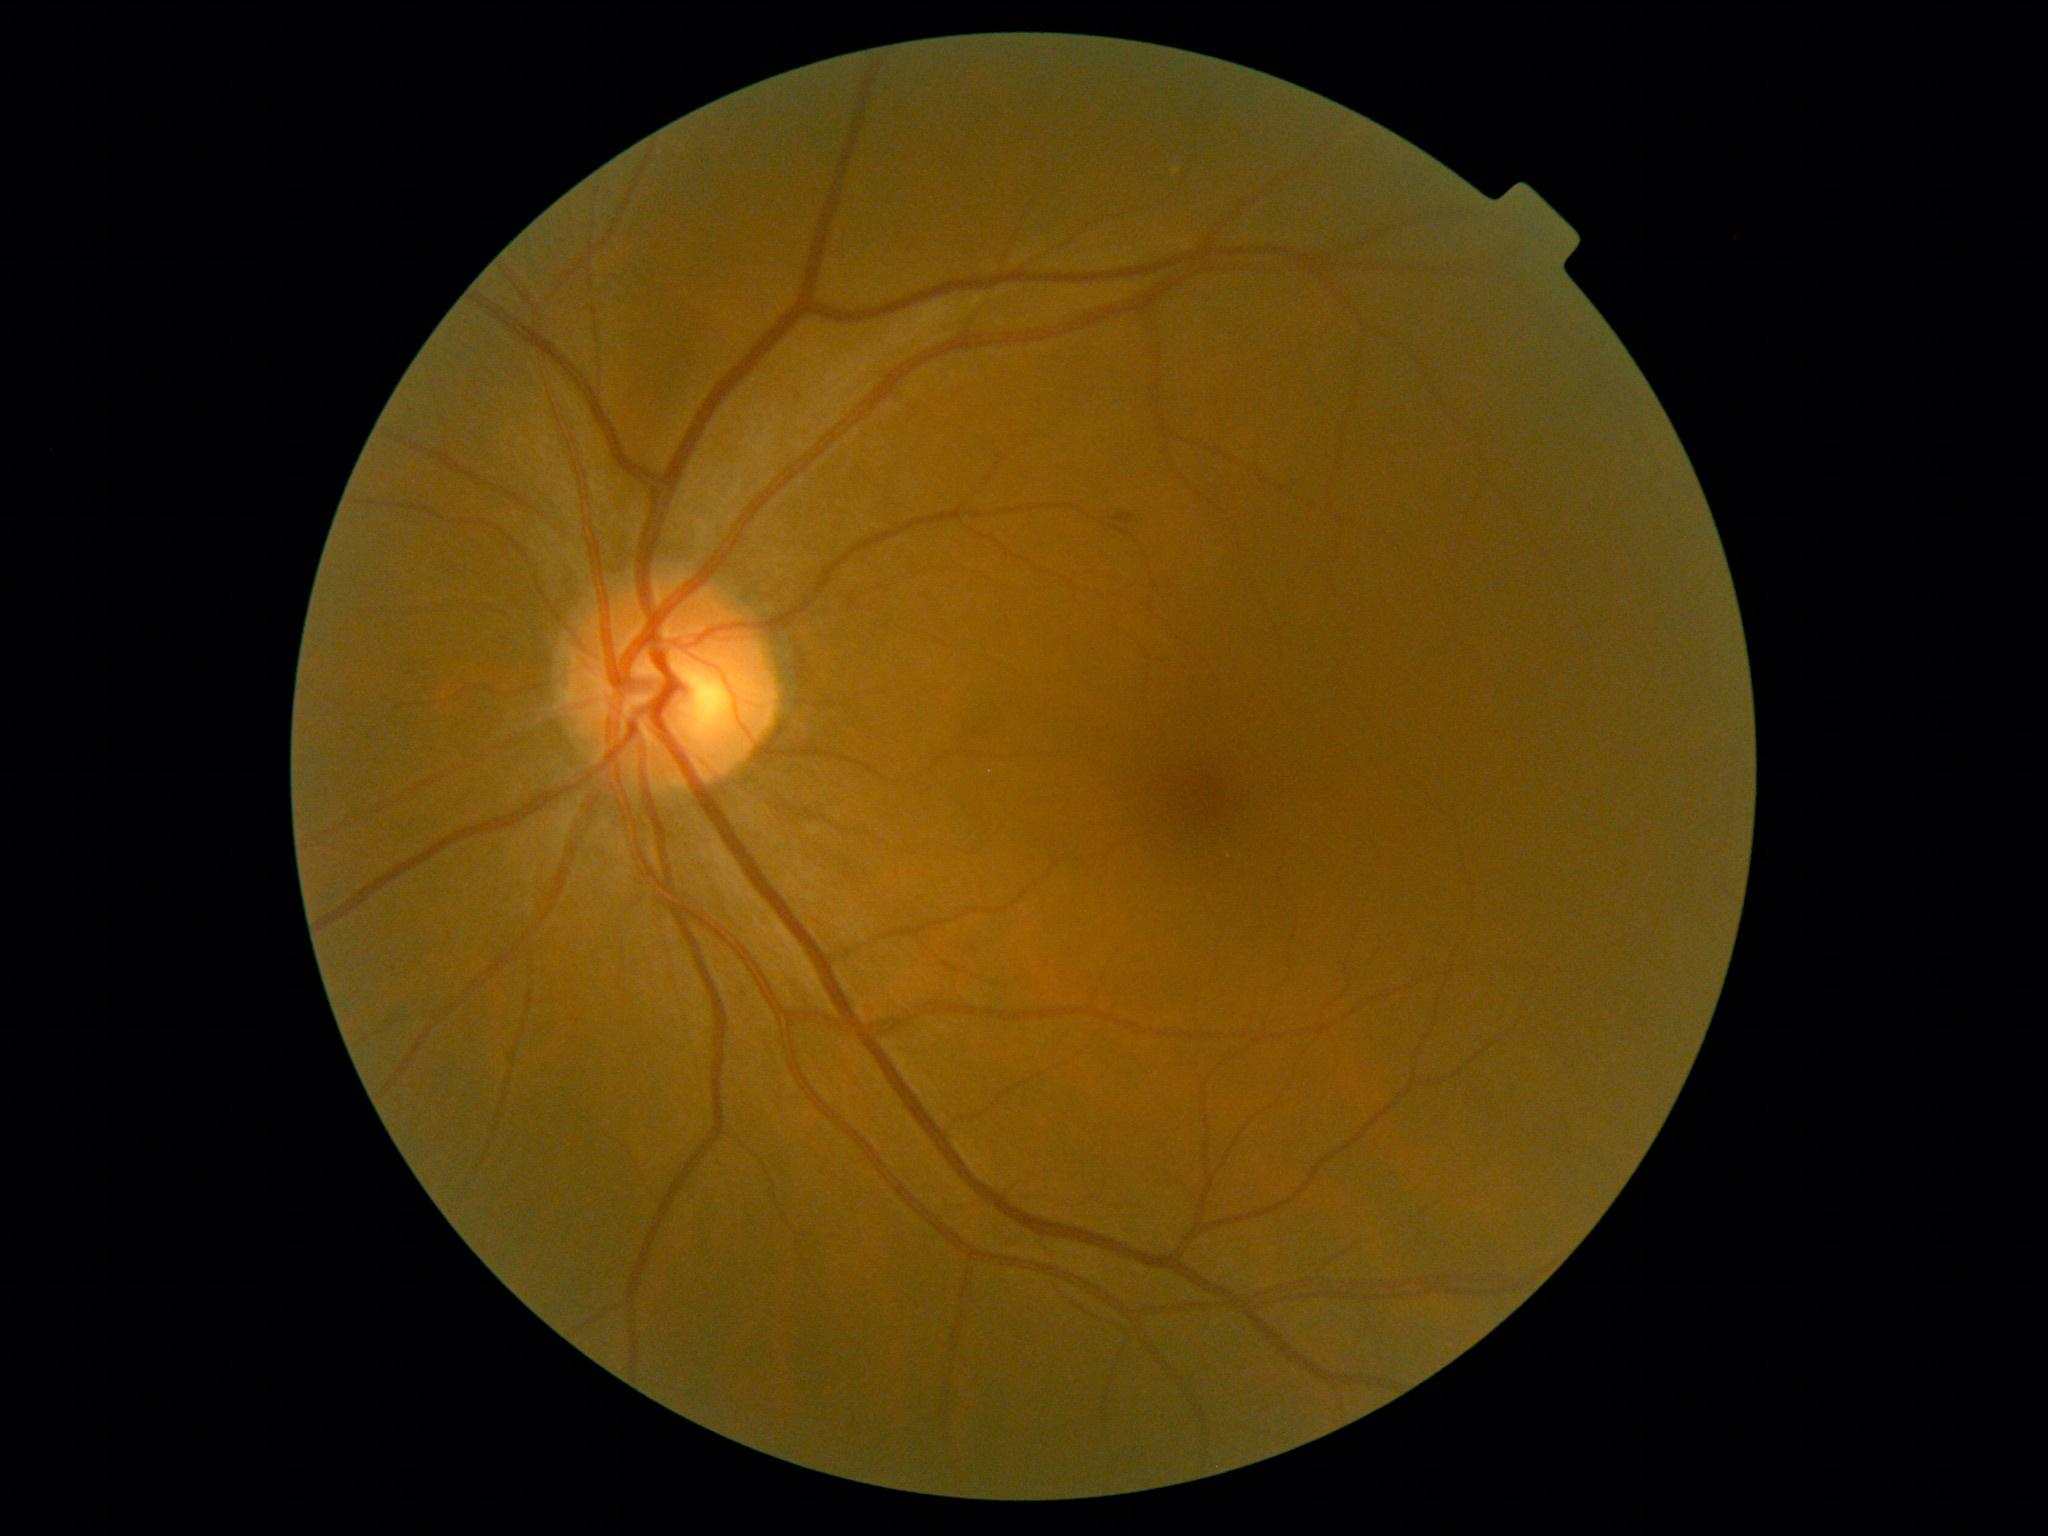

Diabetic retinopathy: grade 1.